Camera: NIDEK AFC-230 · color fundus image · DR severity per modified Davis staging:
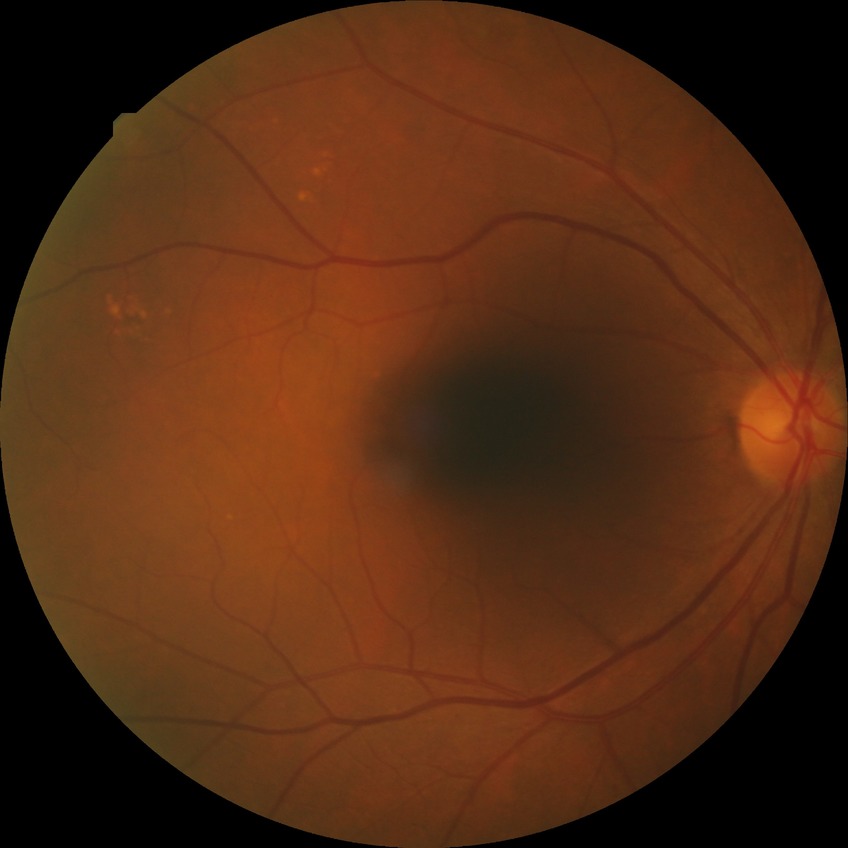 Modified Davis grading is no diabetic retinopathy.